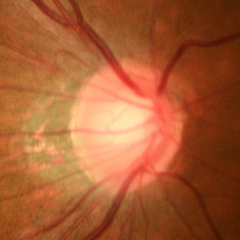

Q: Does this eye have glaucoma?
A: Early glaucomatous optic neuropathy.